Fundus photo.
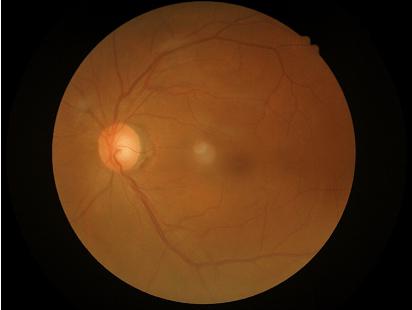

Quality grading: illumination/color: uniform, no color cast; sharpness: out of focus, structures indistinct; overall: adequate for clinical interpretation; contrast: vessels and details readily distinguishable.